Pediatric retinal photograph (wide-field) · 100° field of view (Phoenix ICON): 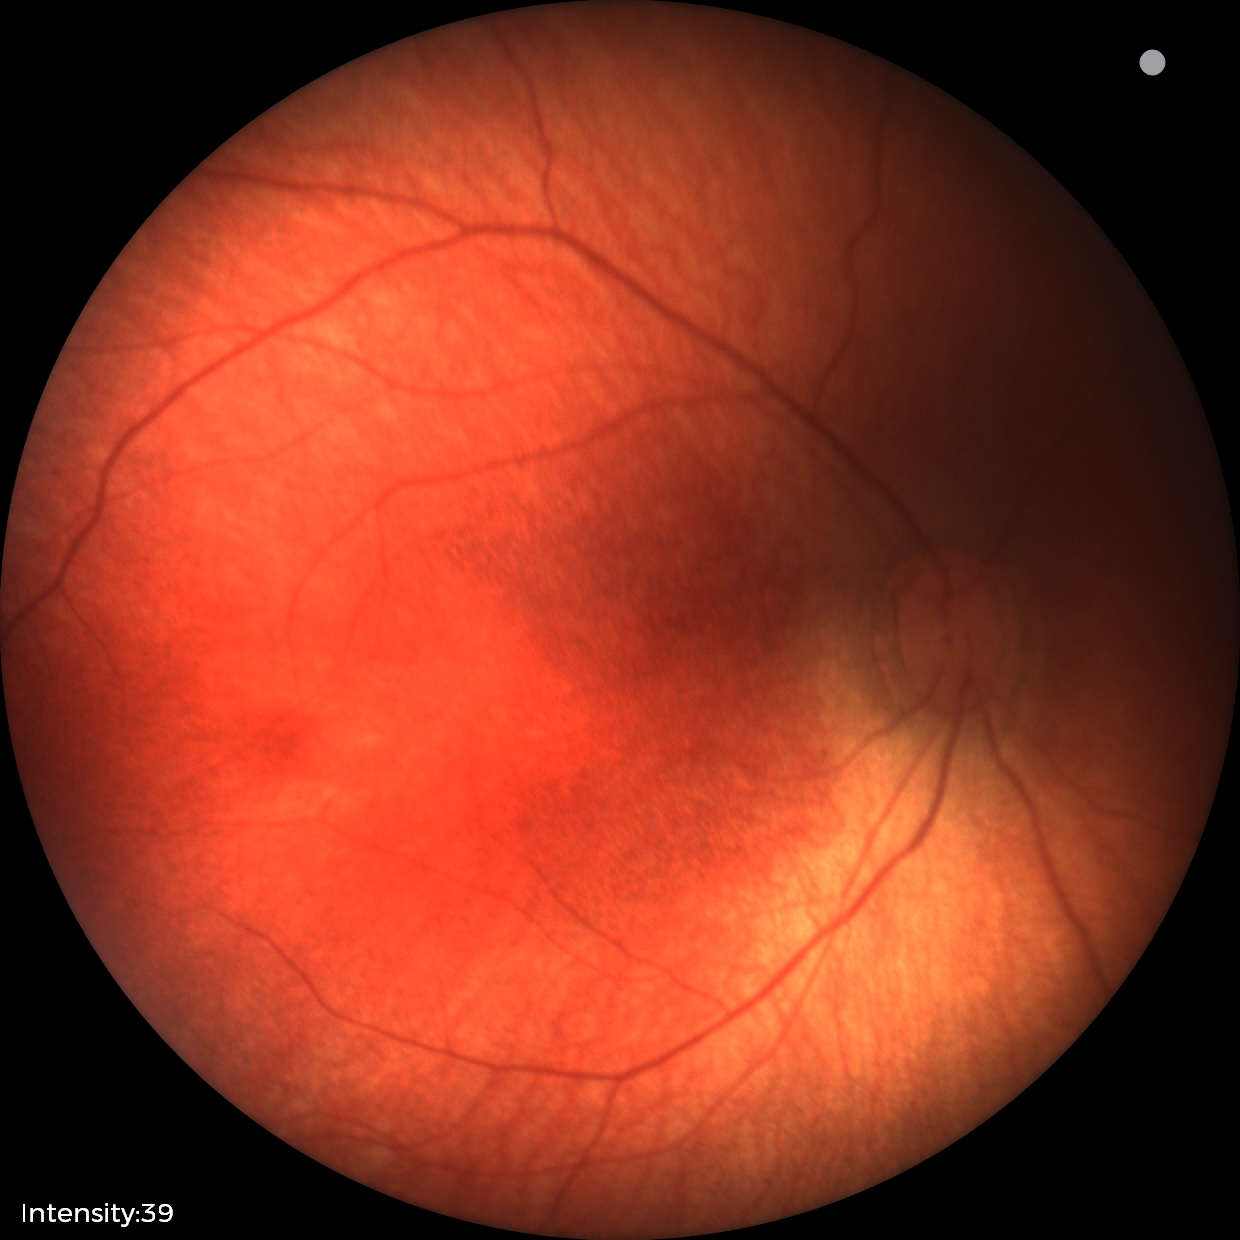
Screening diagnosis: physiological finding.